45-degree field of view. CFP. 2184 by 1690 pixels — 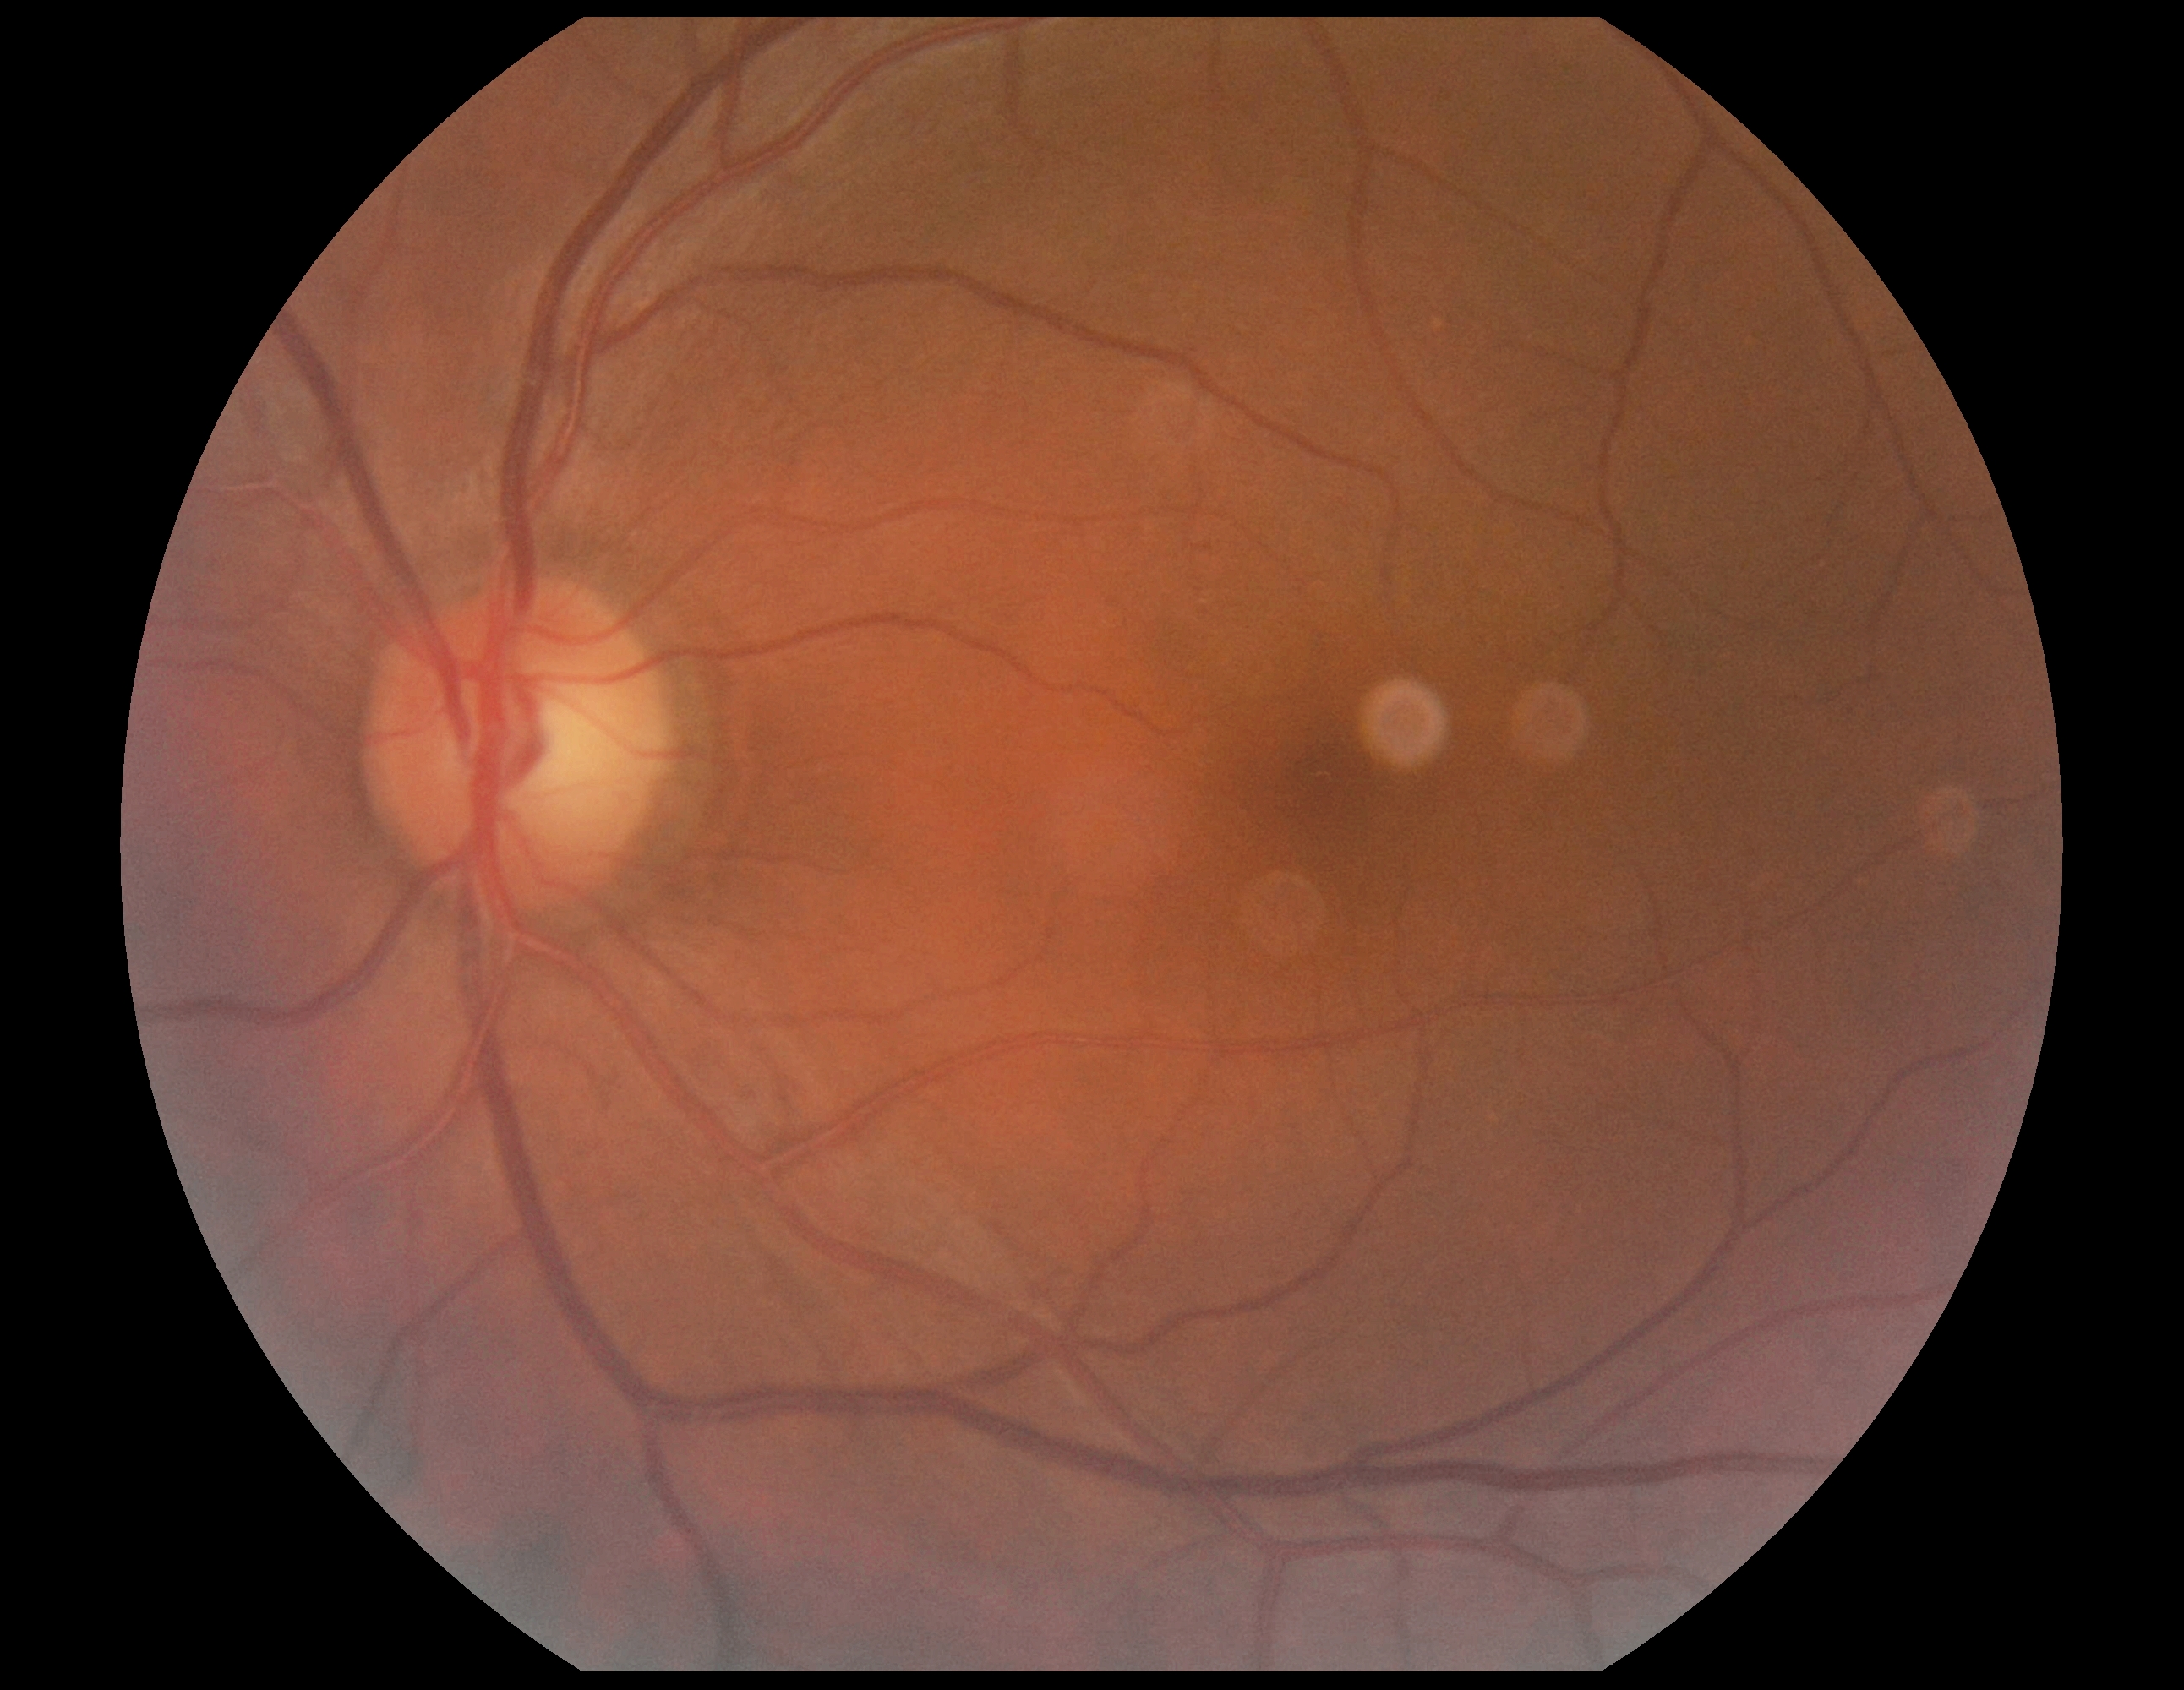
No diabetic retinal disease findings. Diabetic retinopathy severity is grade 0.